Modified Davis classification
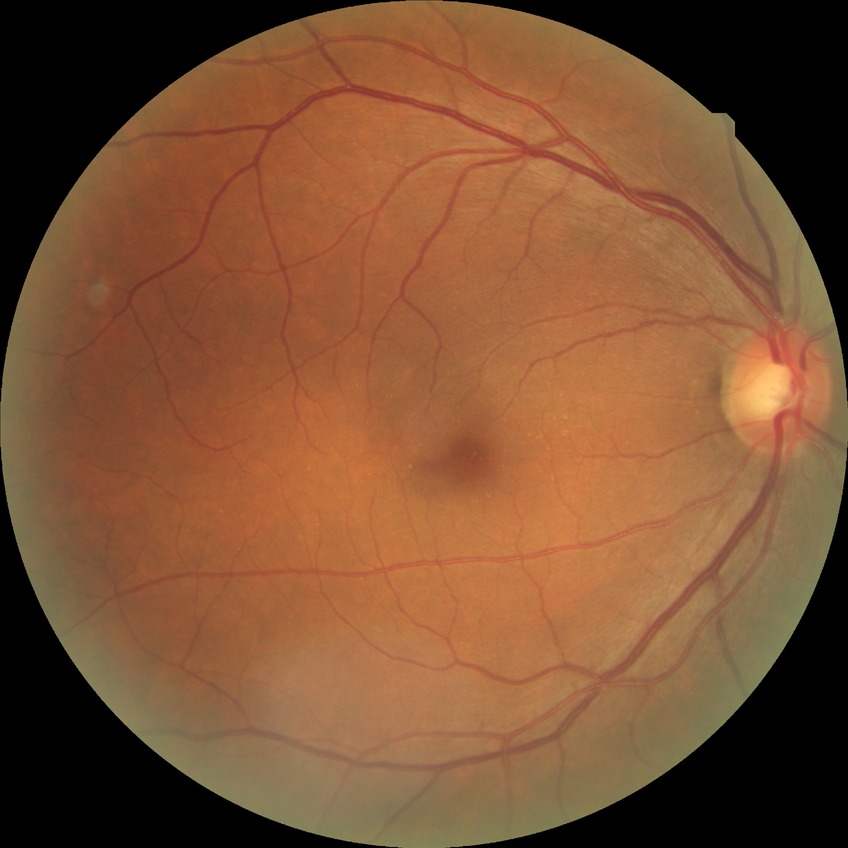

diabetic retinopathy (DR)=NDR (no diabetic retinopathy).